640 by 480 pixels · infant wide-field fundus photograph · Clarity RetCam 3, 130° FOV — 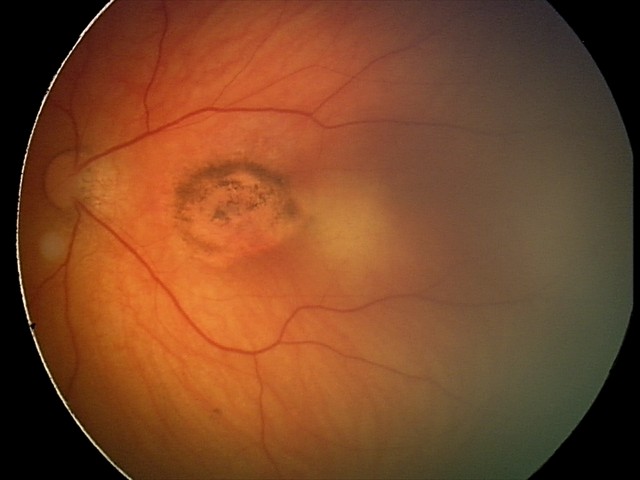 Diagnosis from this screening exam: toxoplasmosis chorioretinitis.